640x480px. Wide-field fundus photograph from neonatal ROP screening
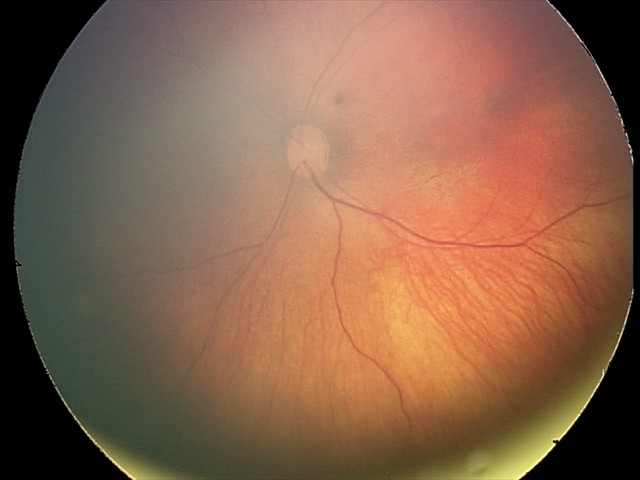

Q: What was the screening finding?
A: retinal hemorrhages